Modified Davis grading:
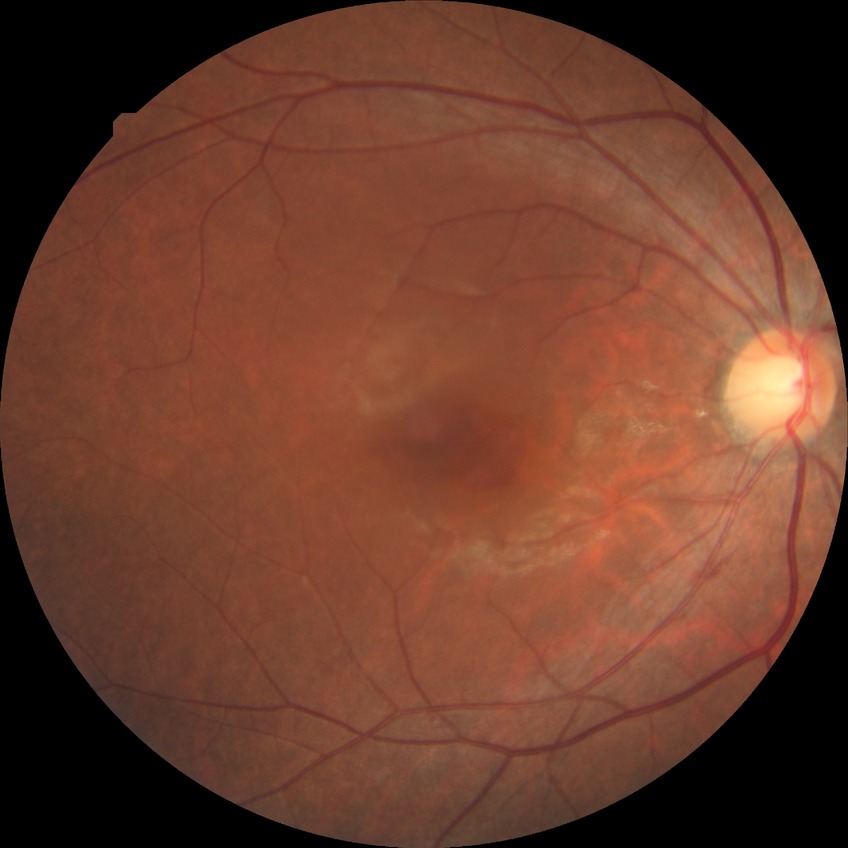 Diabetic retinopathy (DR): NDR (no diabetic retinopathy).